848 x 848 pixels, Davis DR grading
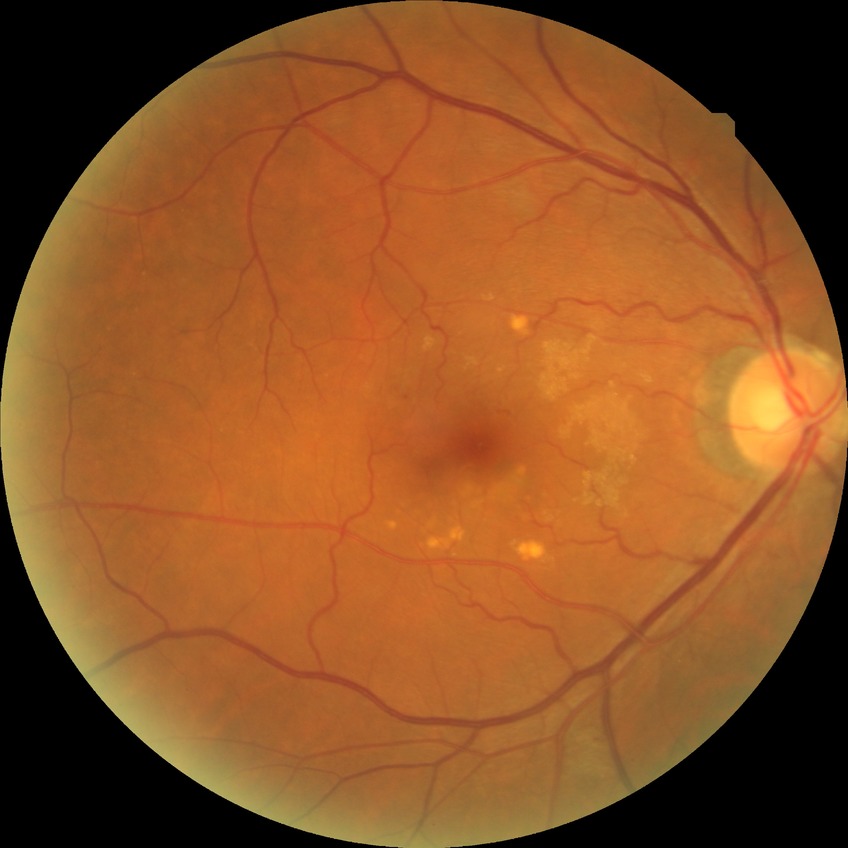

Diabetic retinopathy (DR): simple diabetic retinopathy (SDR).